Wide-field fundus photograph from neonatal ROP screening:
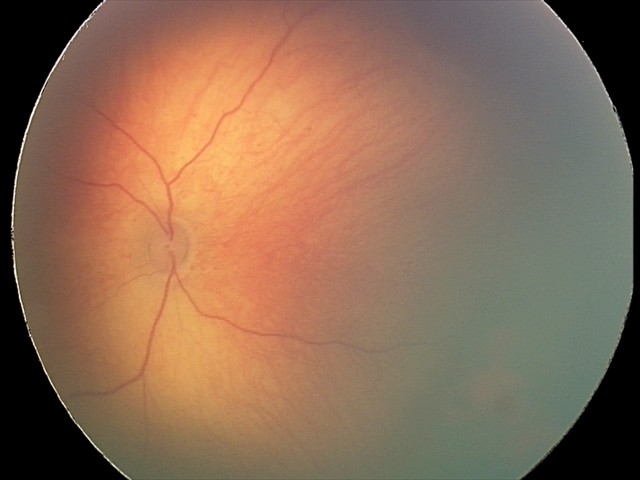
Assessment: retinal hemorrhages.